Modified Davis grading — 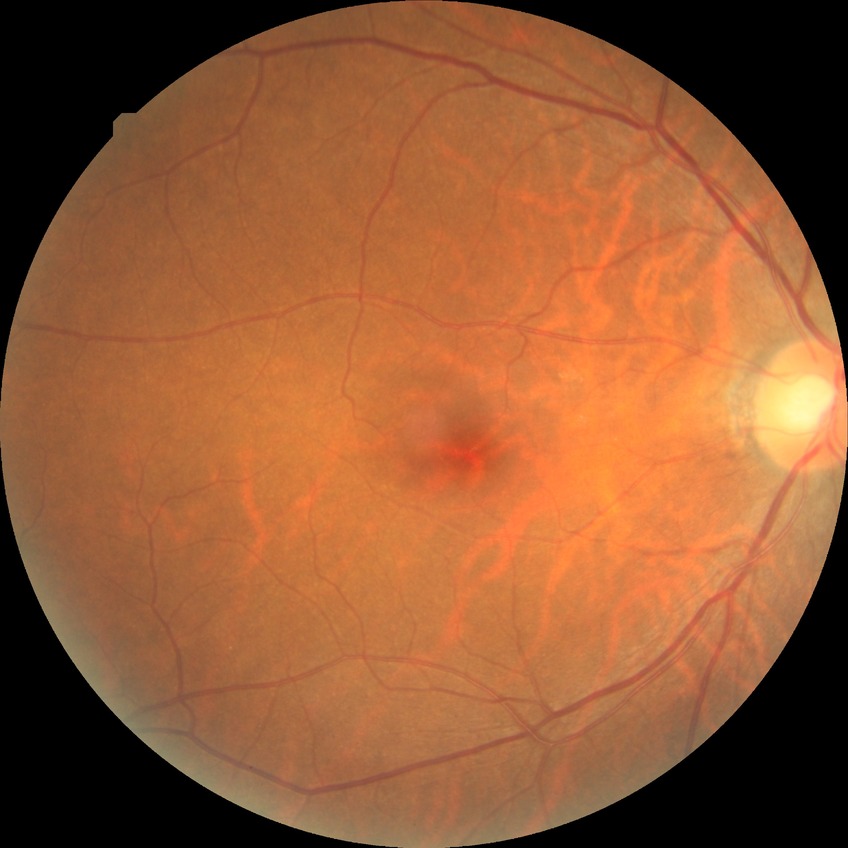

modified Davis grading=no diabetic retinopathy.